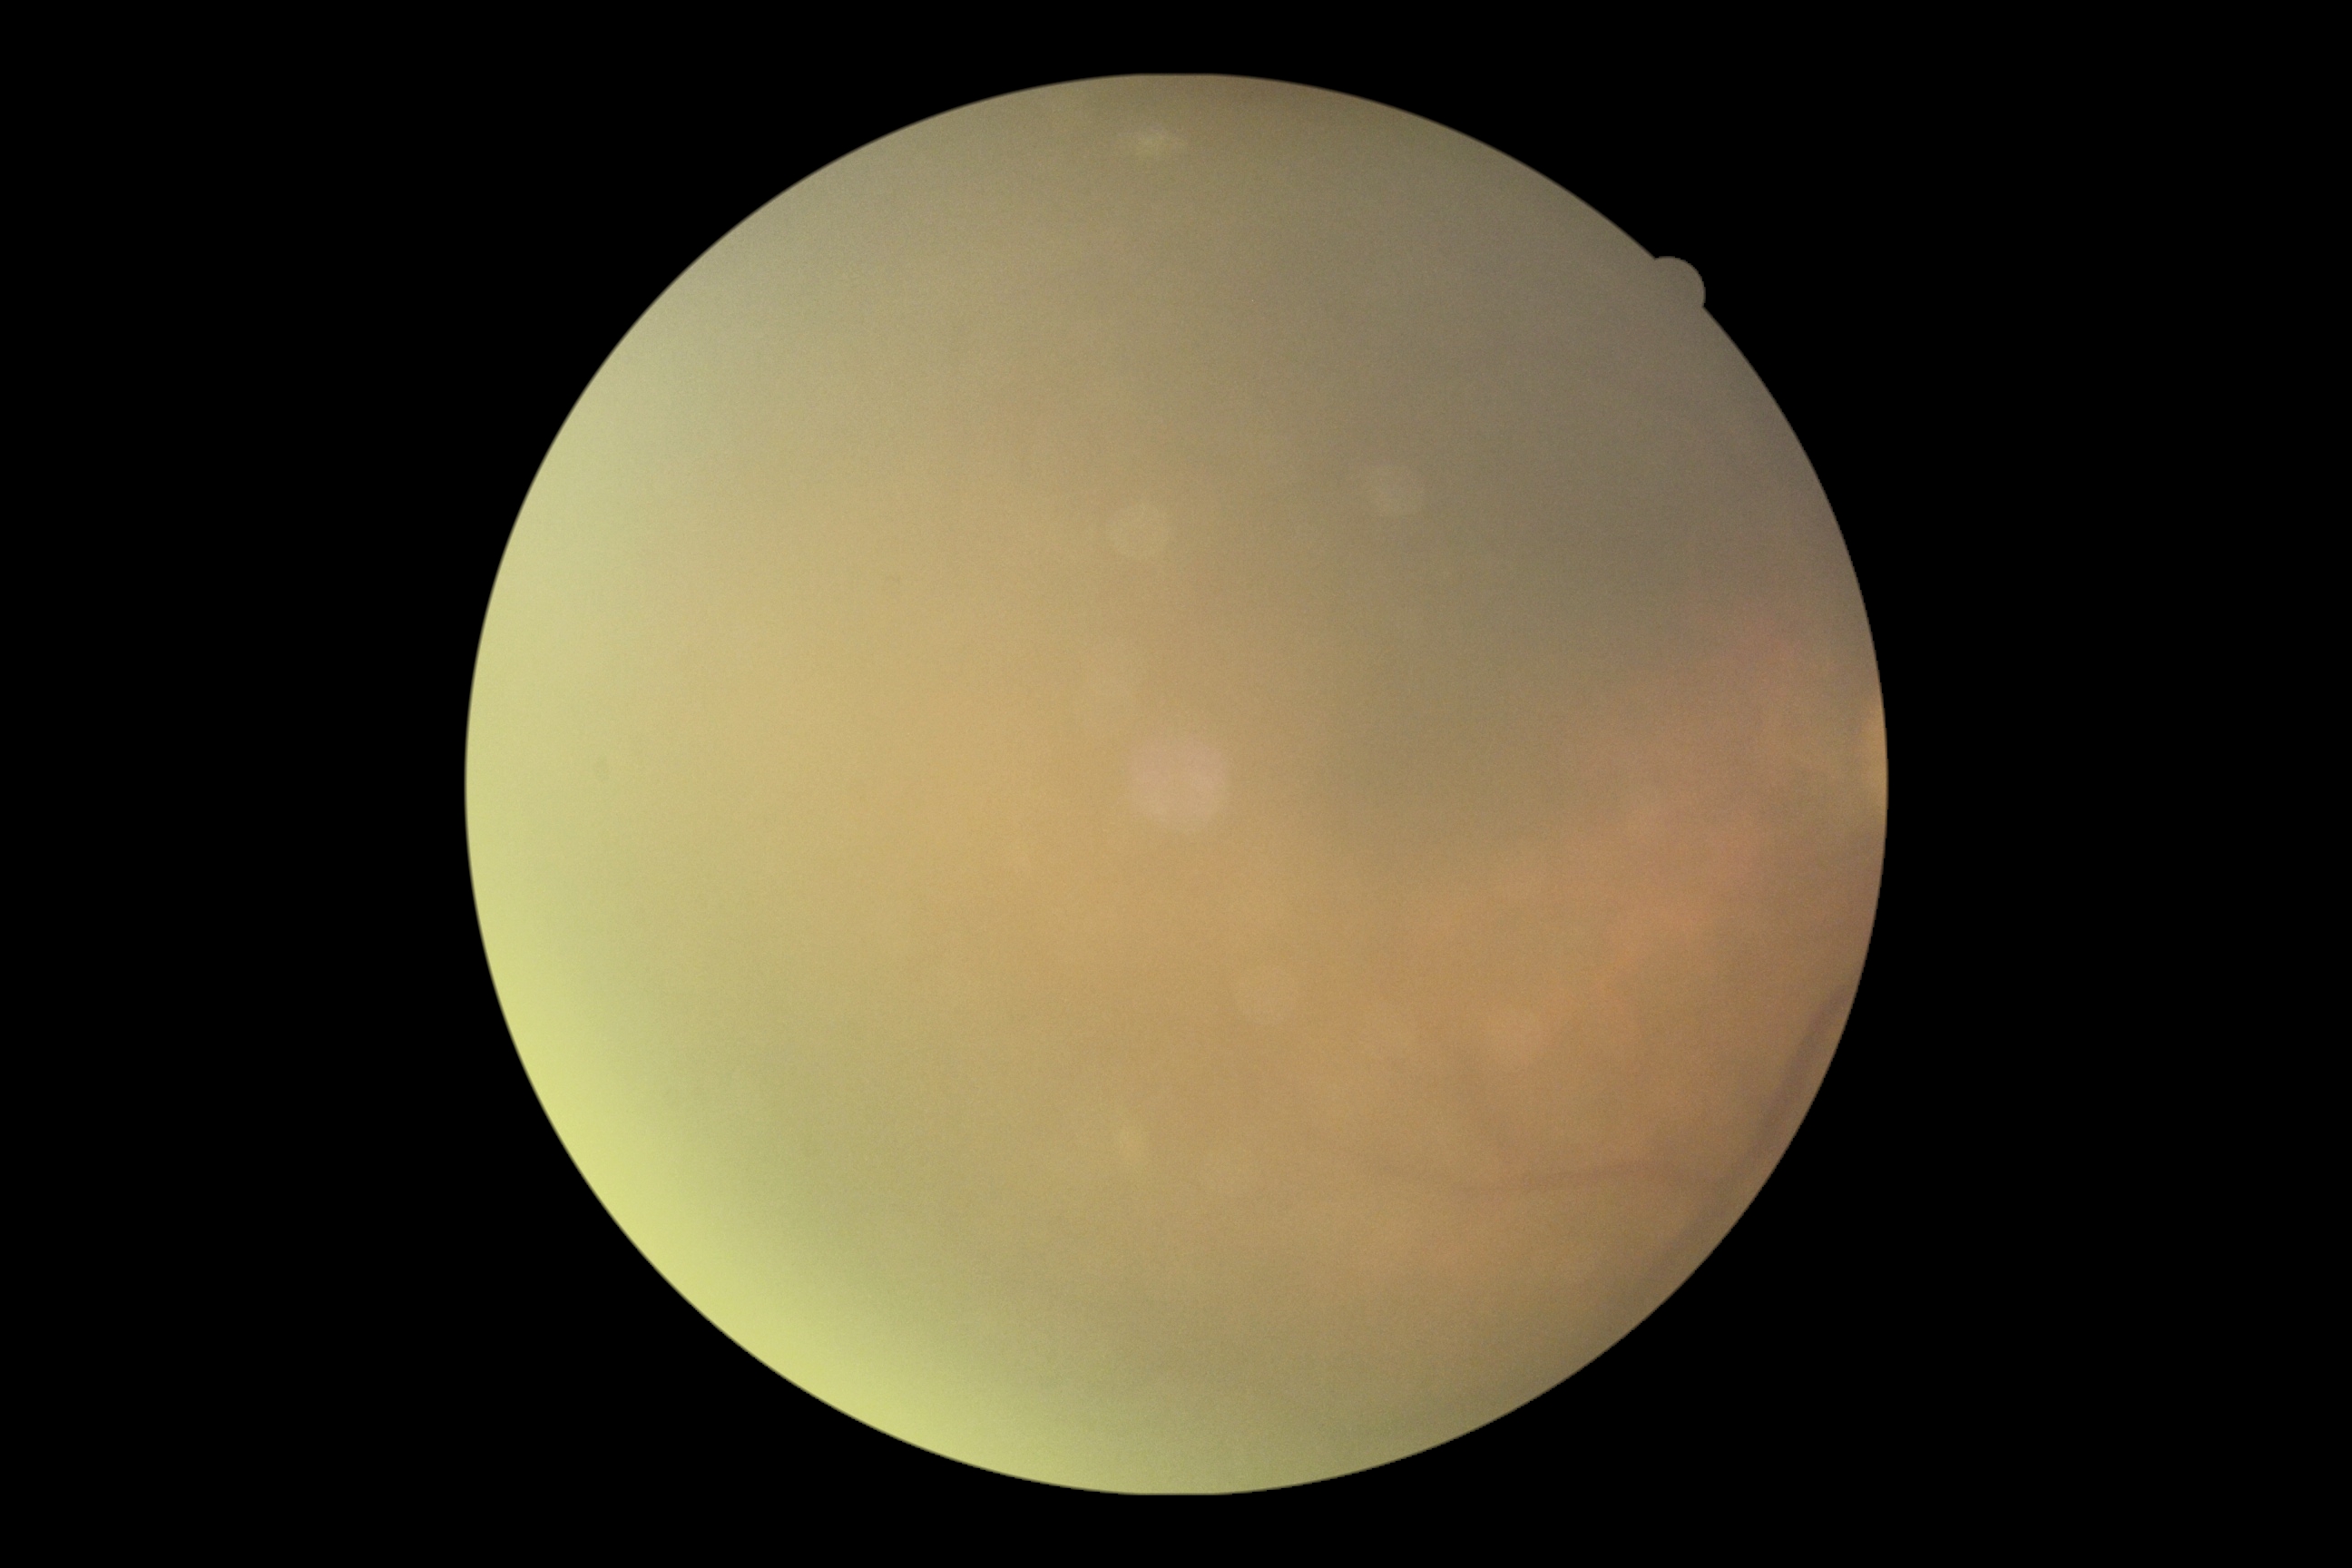
DR grade=ungradable; image quality=insufficient.